45 degree fundus photograph. NIDEK AFC-230. Nonmydriatic fundus photograph. 848x848.
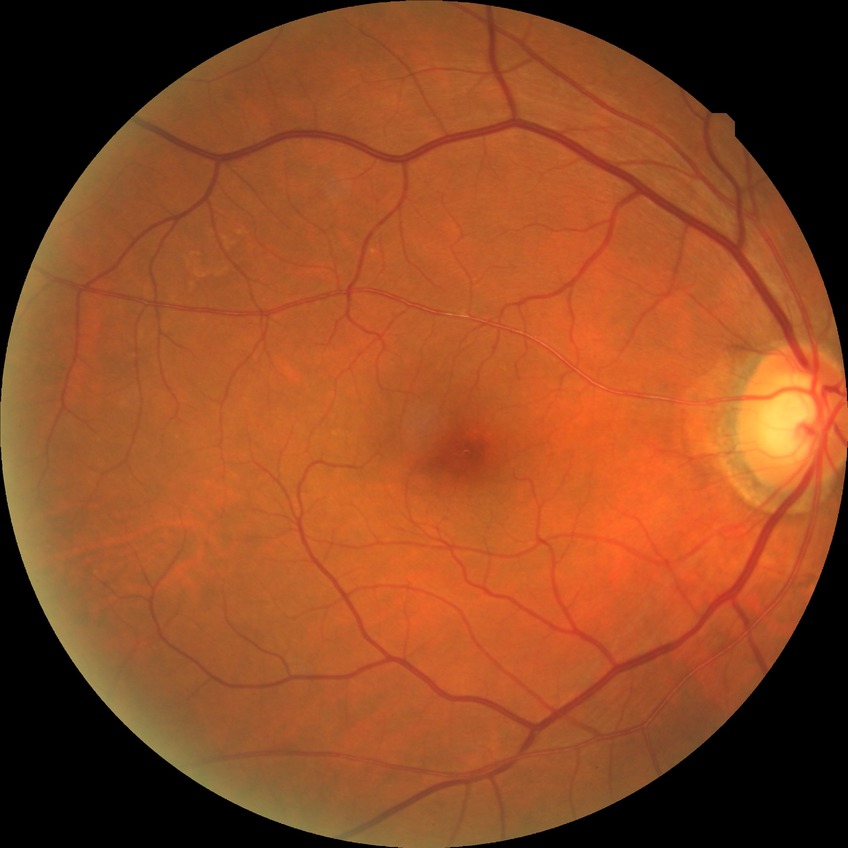 diabetic retinopathy (DR)=no diabetic retinopathy (NDR).